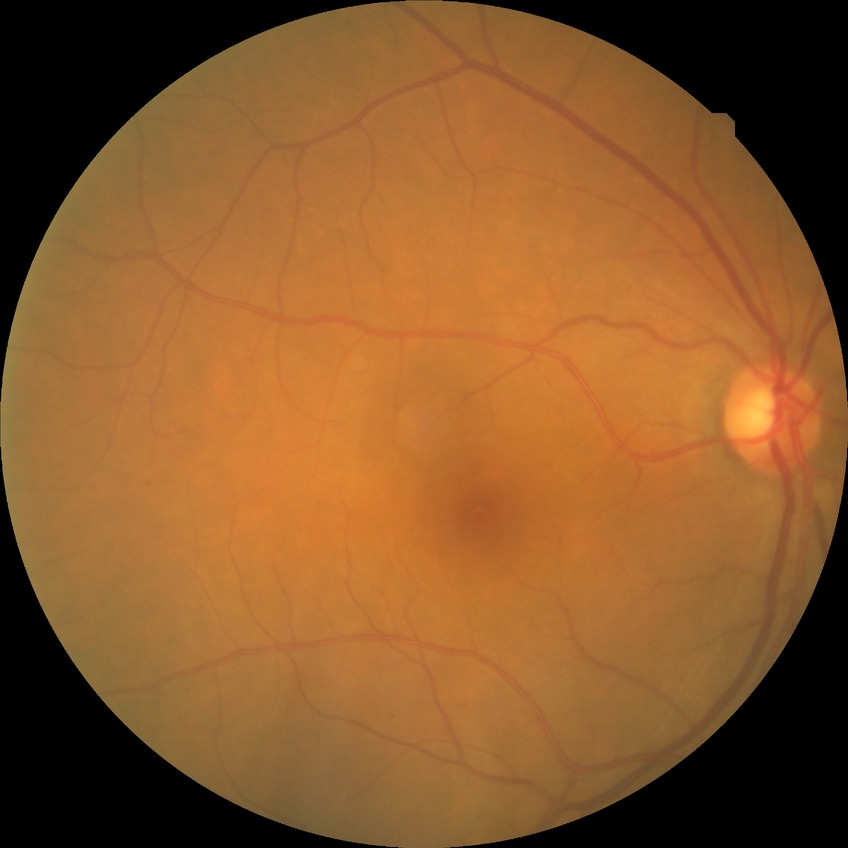
• DR class: non-proliferative diabetic retinopathy
• diabetic retinopathy grade: simple diabetic retinopathy